Color fundus photograph. 512 x 512 pixels.
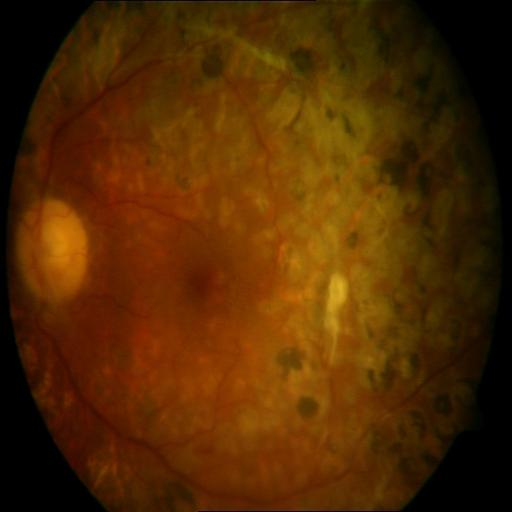

2 abnormalities. Showing laser scars & retinal traction.